Phoenix ICON wide-field infant fundus image · 1240x1240 · Phoenix ICON, 100° FOV — 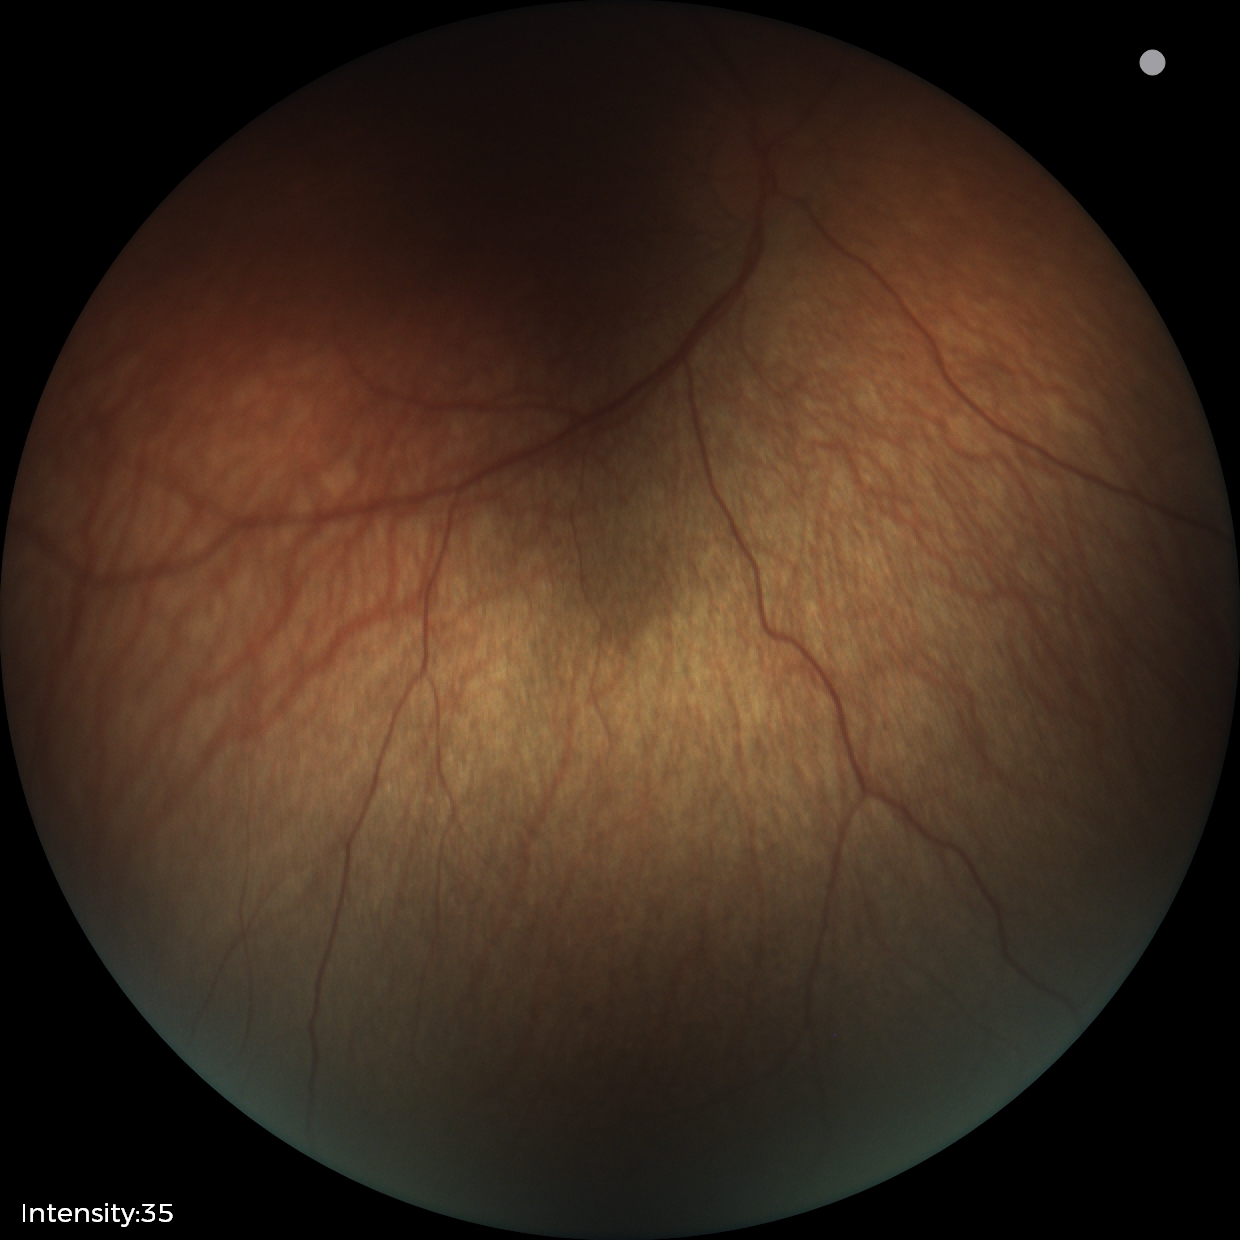
Physiological retinal appearance for postconceptual age.